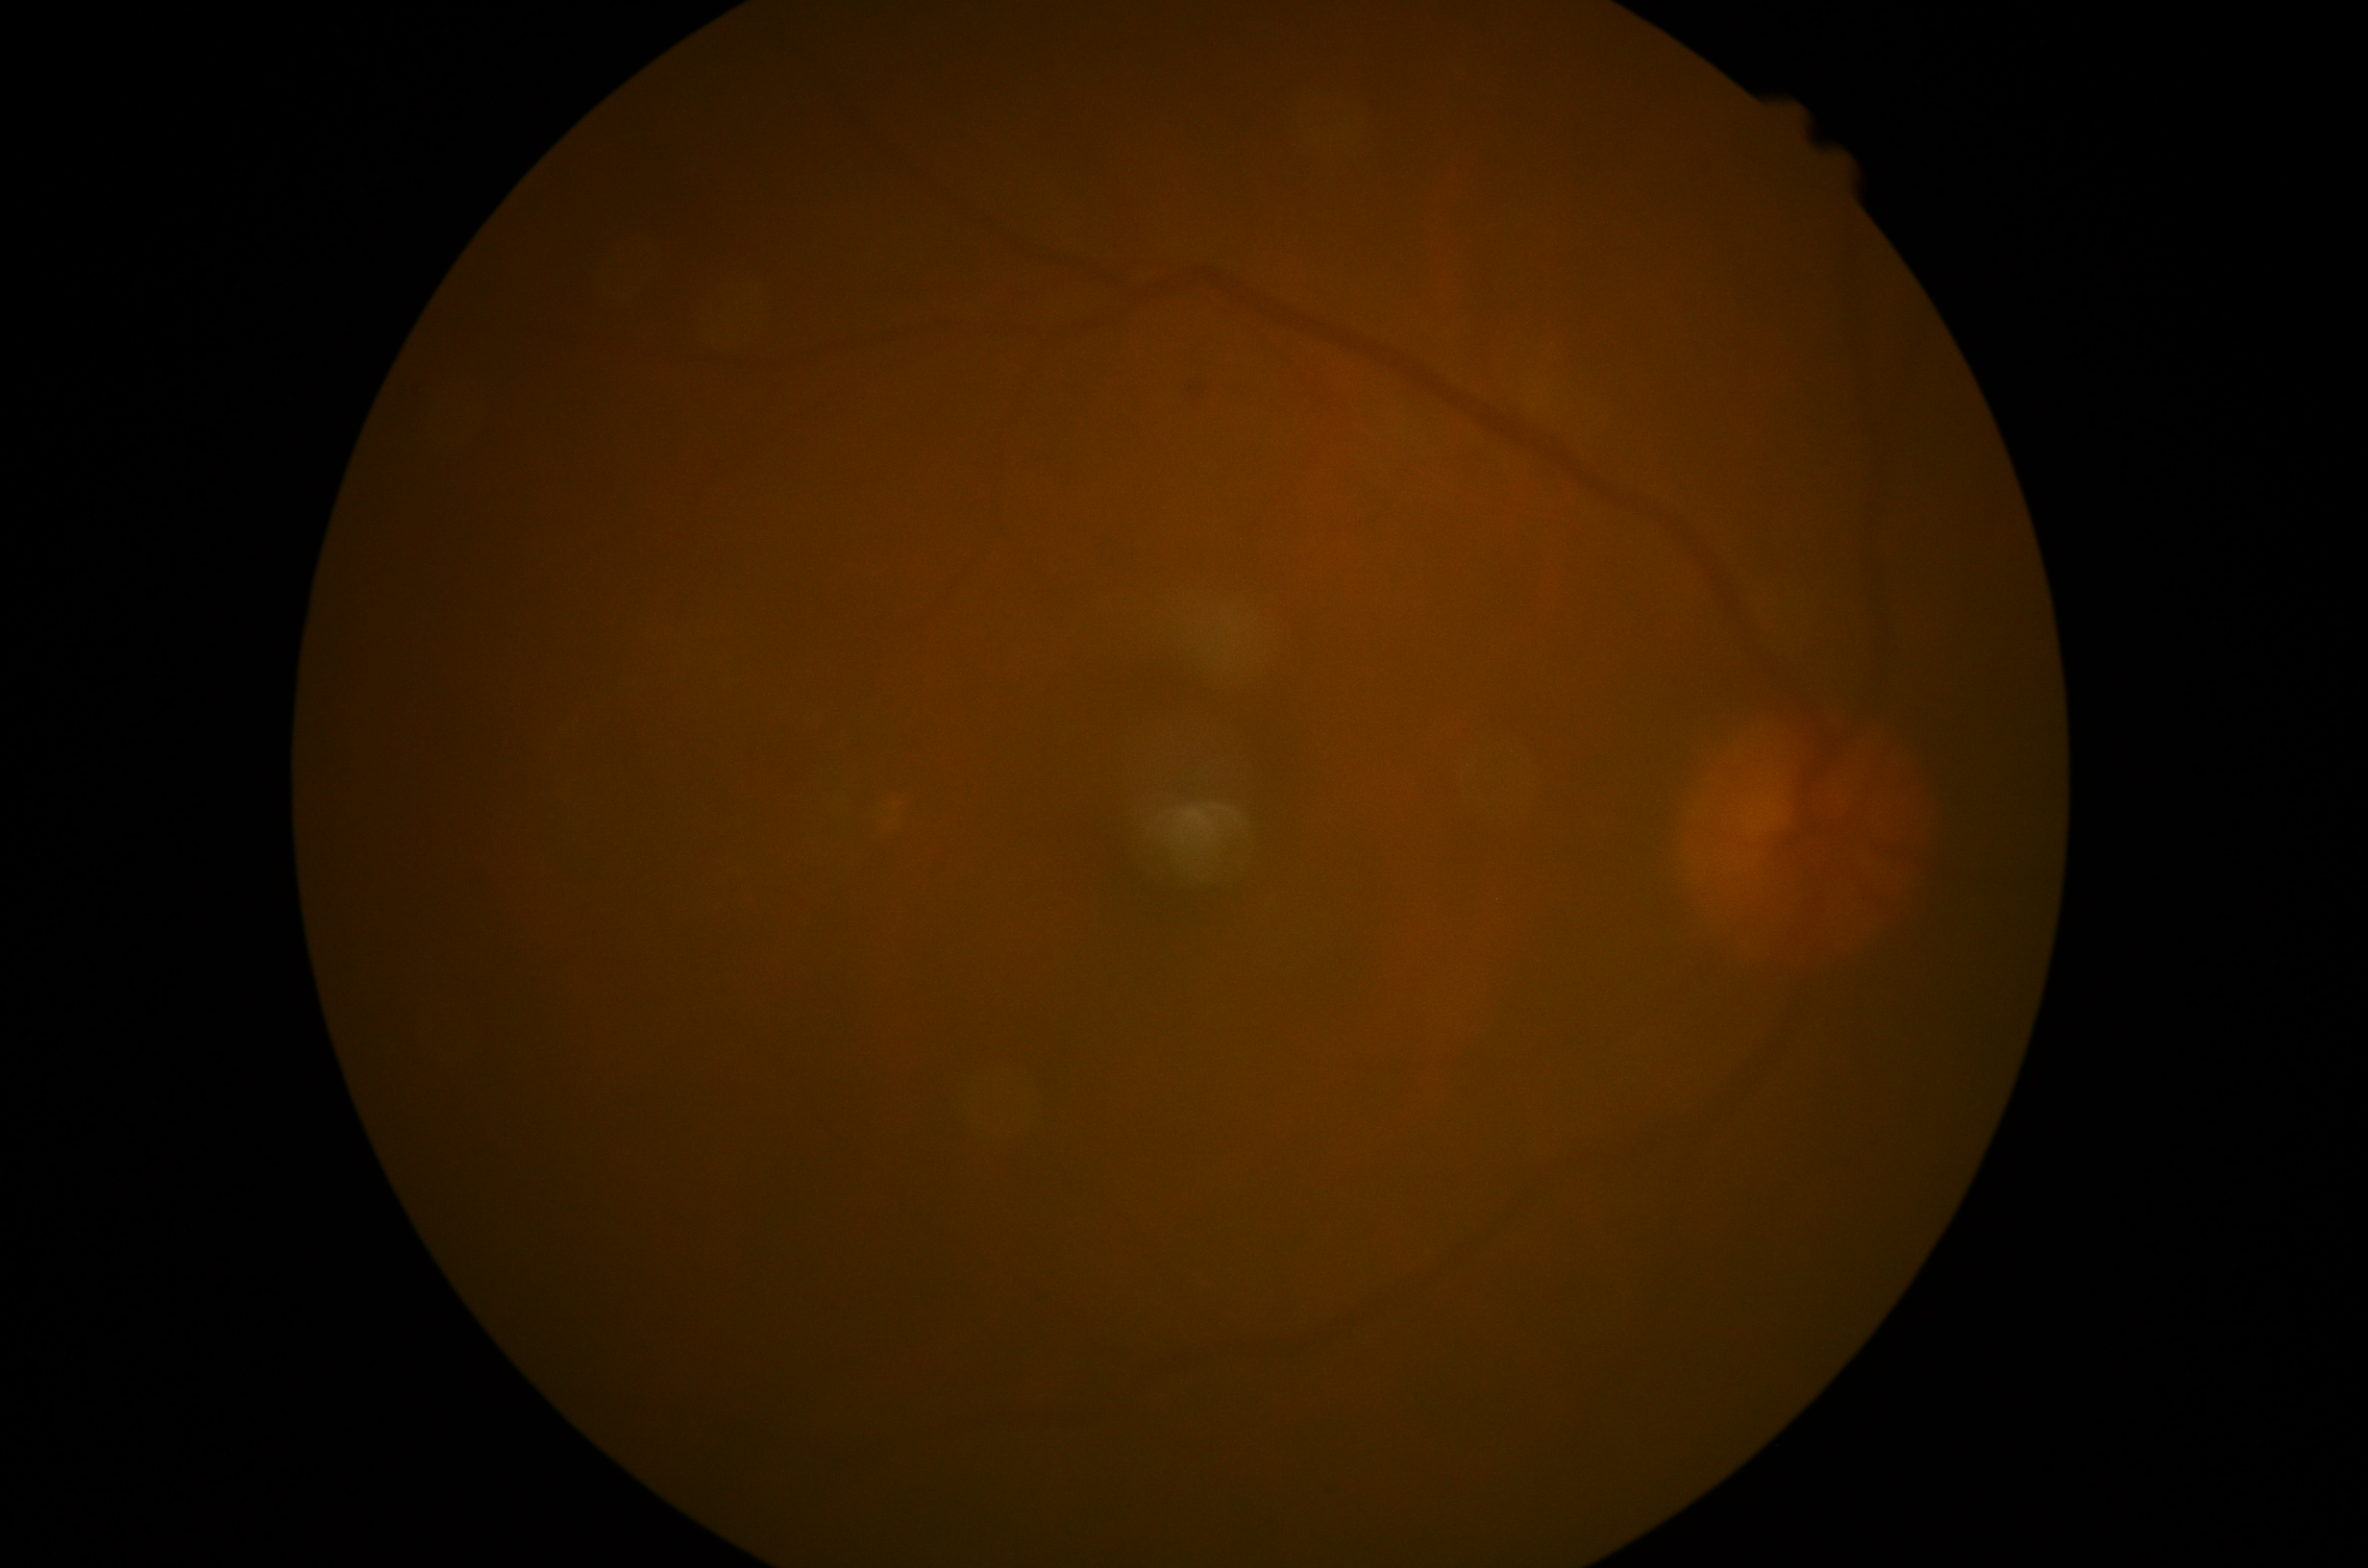 Disease class: non-proliferative diabetic retinopathy.
DR stage: grade 2 (moderate NPDR).